Color fundus photograph.
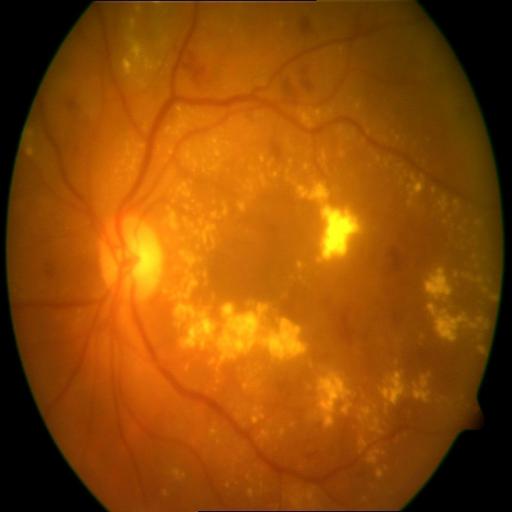
Diagnosis:
- EDN (exudation)
- HR (hemorrhagic retinopathy)